Acquired with a NIDEK AFC-230
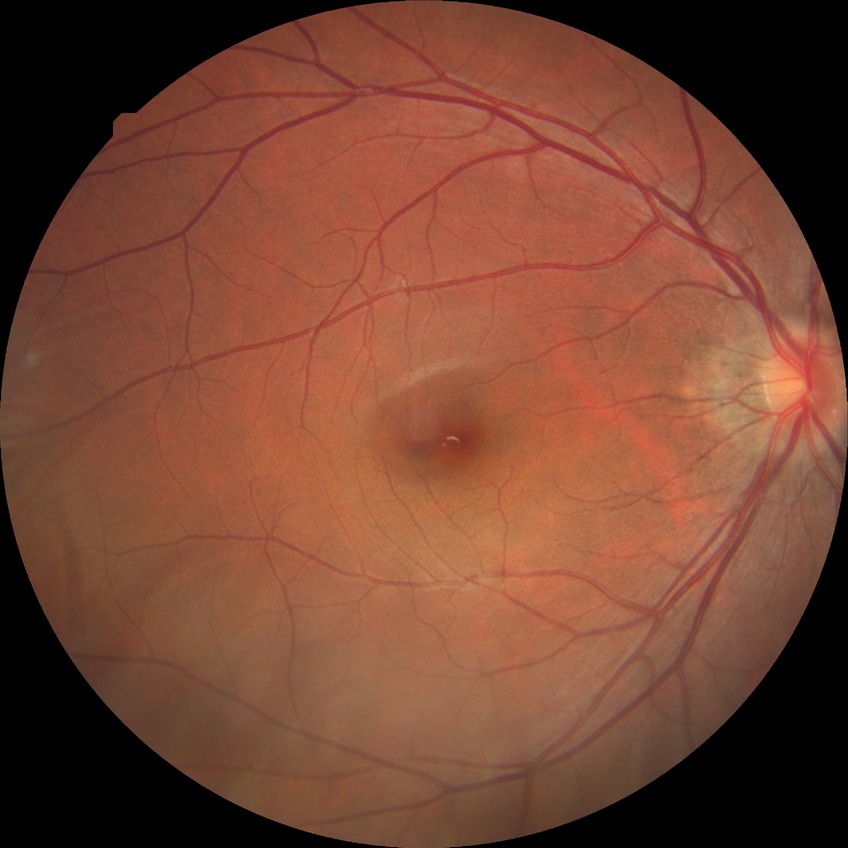
Diabetic retinopathy (DR): NDR (no diabetic retinopathy).